Tabletop color fundus camera image.
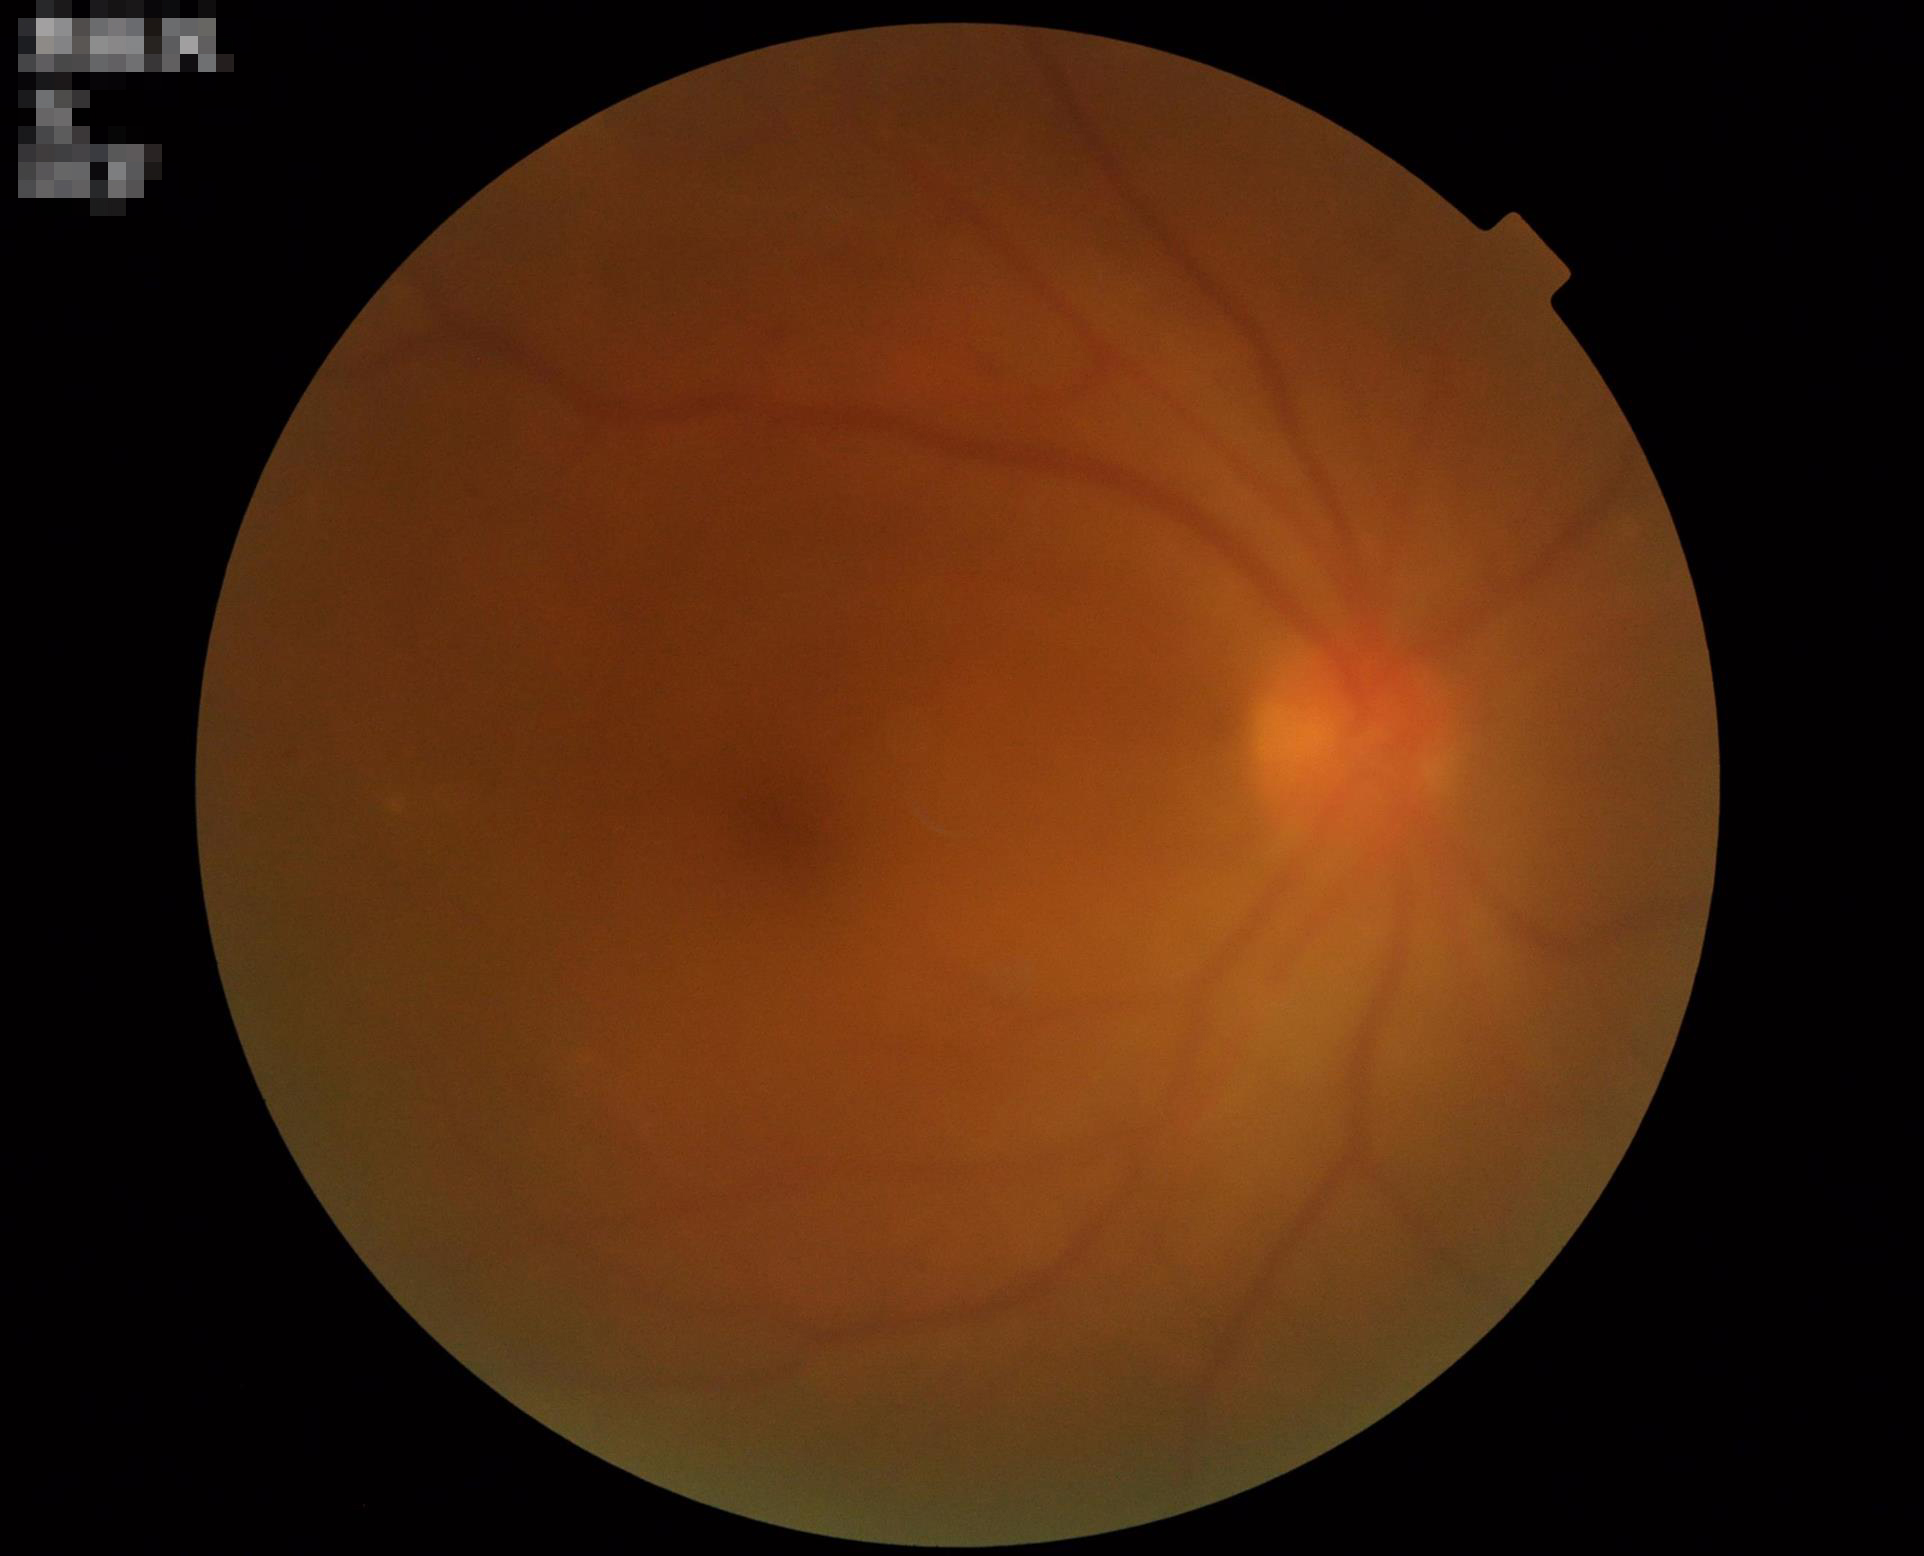

Overall image quality = poor, ungradable
Contrast = wide intensity range, structures distinguishable
Illumination/color = uniform, no color cast
Sharpness = reduced sharpness with visible blur